Retinal fundus photograph
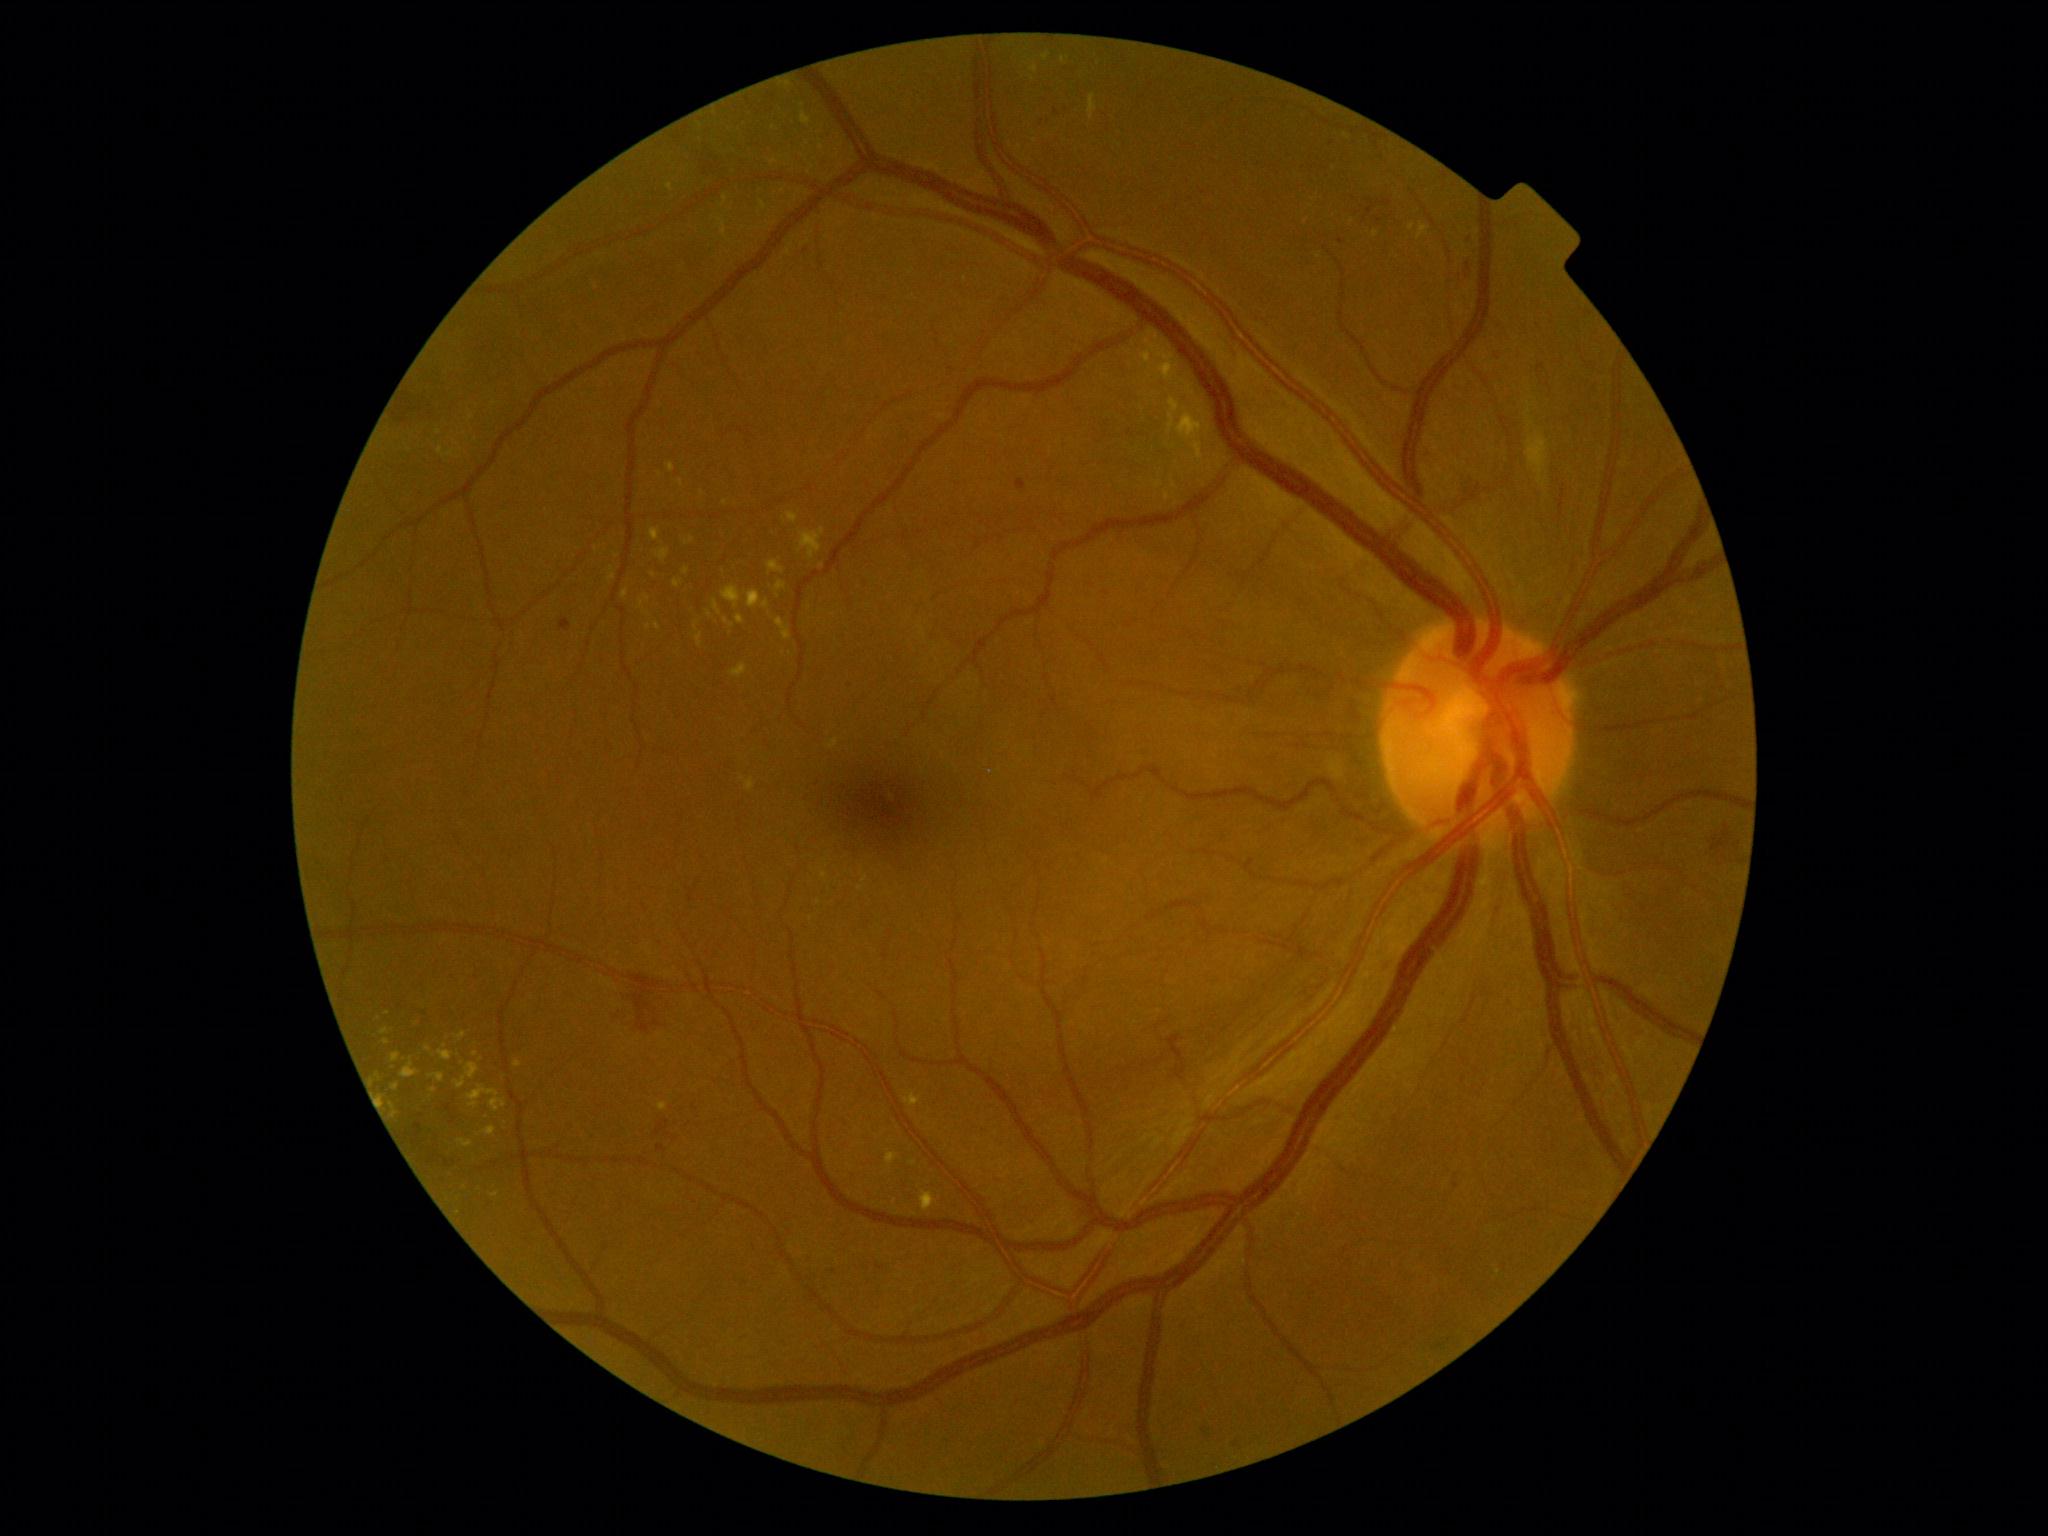

Diabetic retinopathy (DR): moderate NPDR (grade 2); non-proliferative diabetic retinopathy. Hard exudates (EXs) are present, including at 905,1091,921,1107 | 380,1028,390,1035 | 1145,354,1155,367 | 674,579,683,588 | 1168,397,1203,462 | 640,599,644,608 | 719,219,727,238 | 723,195,729,204 | 622,591,628,599 | 1172,479,1178,489 | 657,549,670,562 | 696,634,703,648 | 921,1190,938,1212 | 412,1014,420,1029. Smaller EXs around {"x": 388, "y": 1013} | {"x": 810, "y": 607} | {"x": 660, "y": 474} | {"x": 654, "y": 575} | {"x": 1352, "y": 221} | {"x": 1375, "y": 234}. Microaneurysms (MAs) identified at 1538,364,1545,374 | 806,1255,813,1263 | 1466,232,1473,245 | 559,618,572,632 | 1017,479,1027,490. Smaller MAs around {"x": 834, "y": 1271} | {"x": 1332, "y": 144} | {"x": 1342, "y": 241}. Soft exudates (SEs) identified at 1526,433,1549,486. Smaller SEs around {"x": 1531, "y": 423} | {"x": 1530, "y": 406} | {"x": 1529, "y": 412}. Hemorrhages (HEs) are present, including at 1383,201,1393,207 | 1037,102,1069,129 | 612,972,661,1032 | 876,1265,885,1270 | 1558,486,1566,516 | 1232,1435,1245,1445 | 803,238,808,257 | 392,387,446,427 | 1202,1418,1212,1438. Smaller HEs around {"x": 1379, "y": 203} | {"x": 1379, "y": 221}.